45° FOV. Color fundus photograph
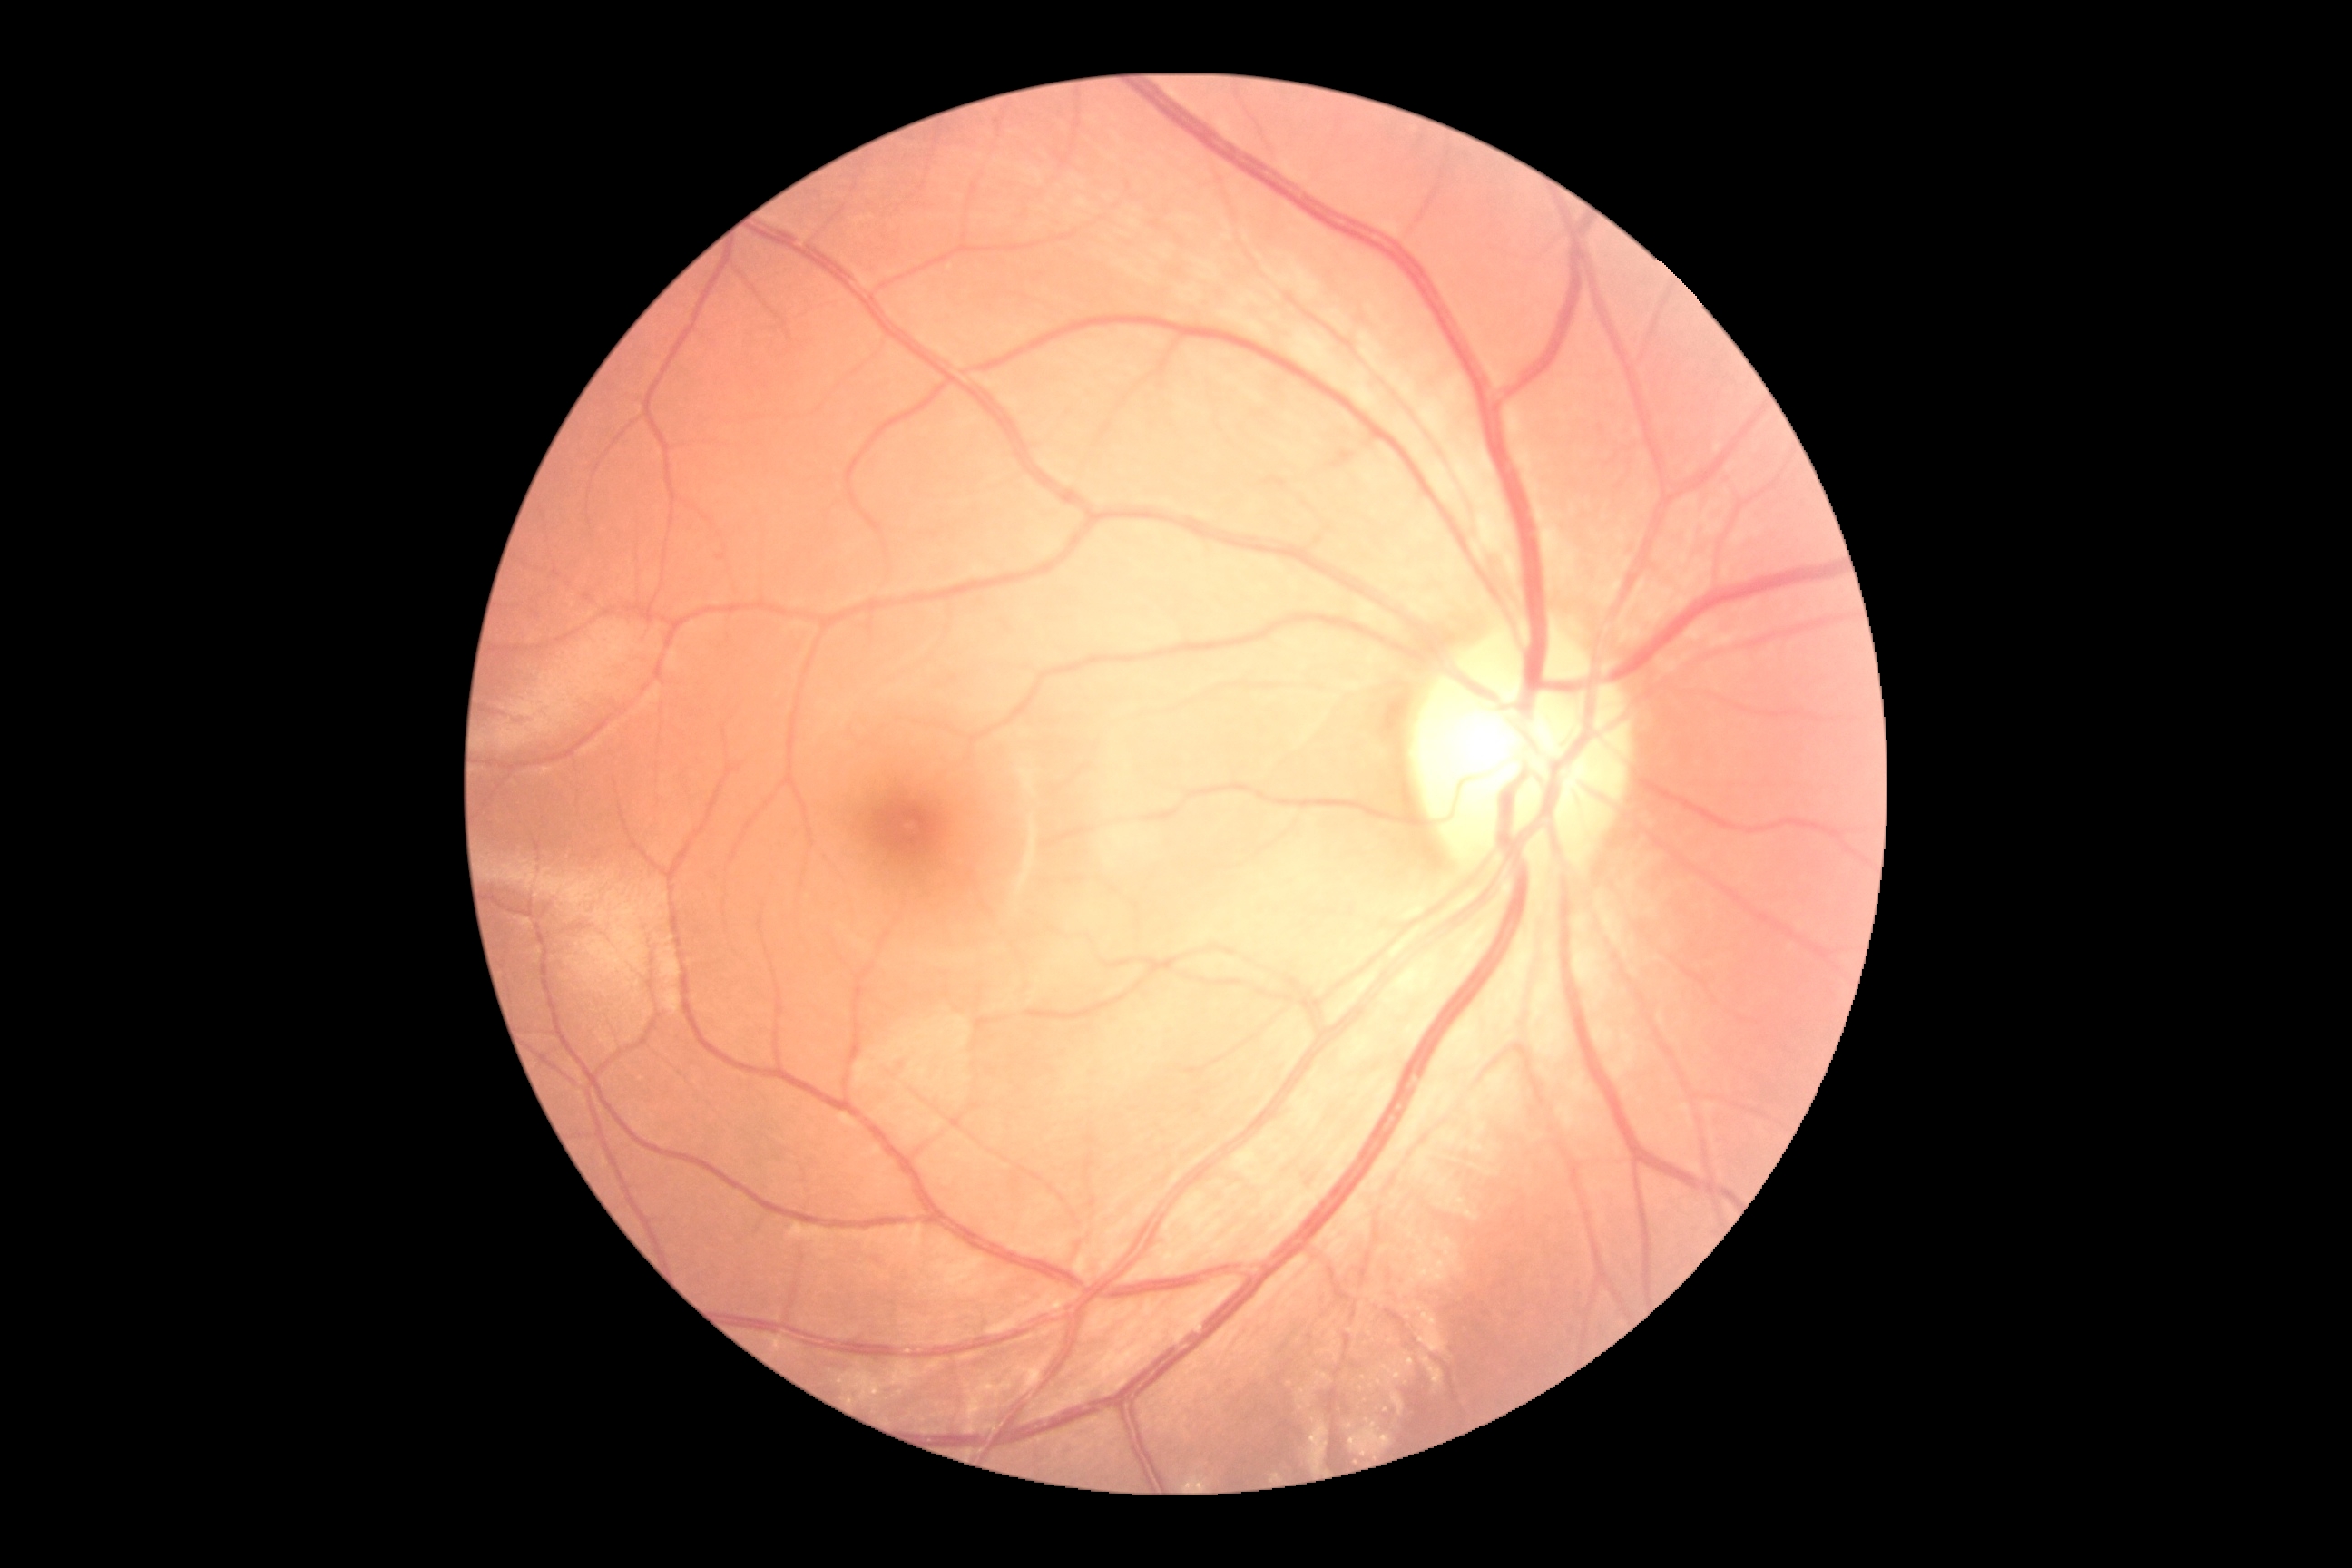 No diabetic retinal disease findings.
Diabetic retinopathy severity: 0/4.